Fundus photo; modified Davis grading; FOV: 45 degrees; nonmydriatic: 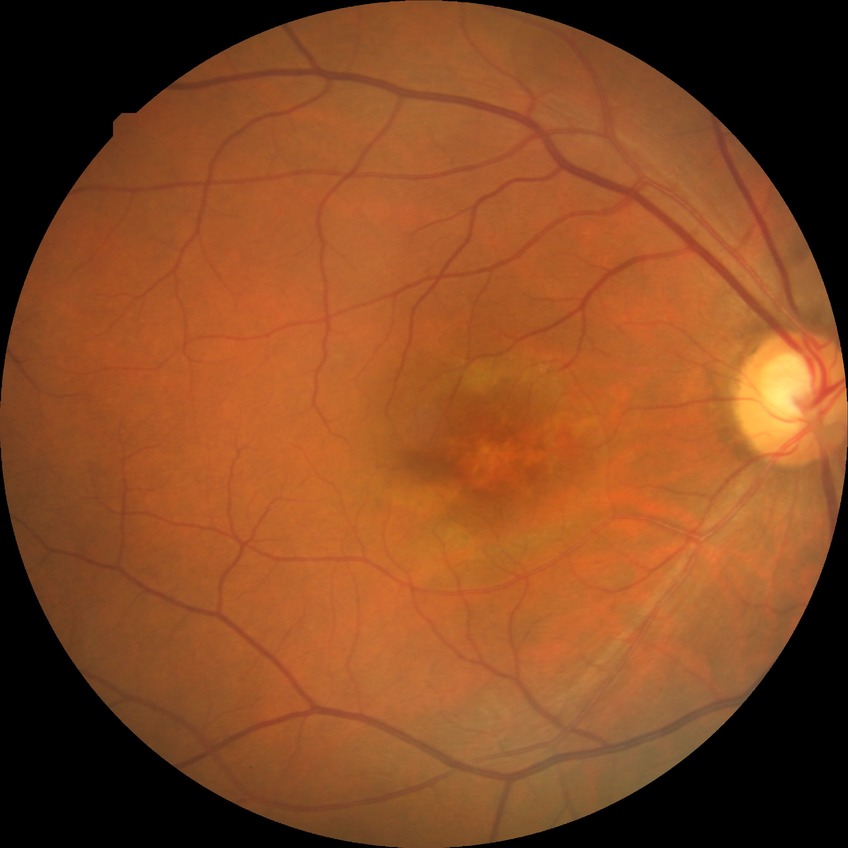 Retinopathy grade: no diabetic retinopathy.